Color fundus photograph.
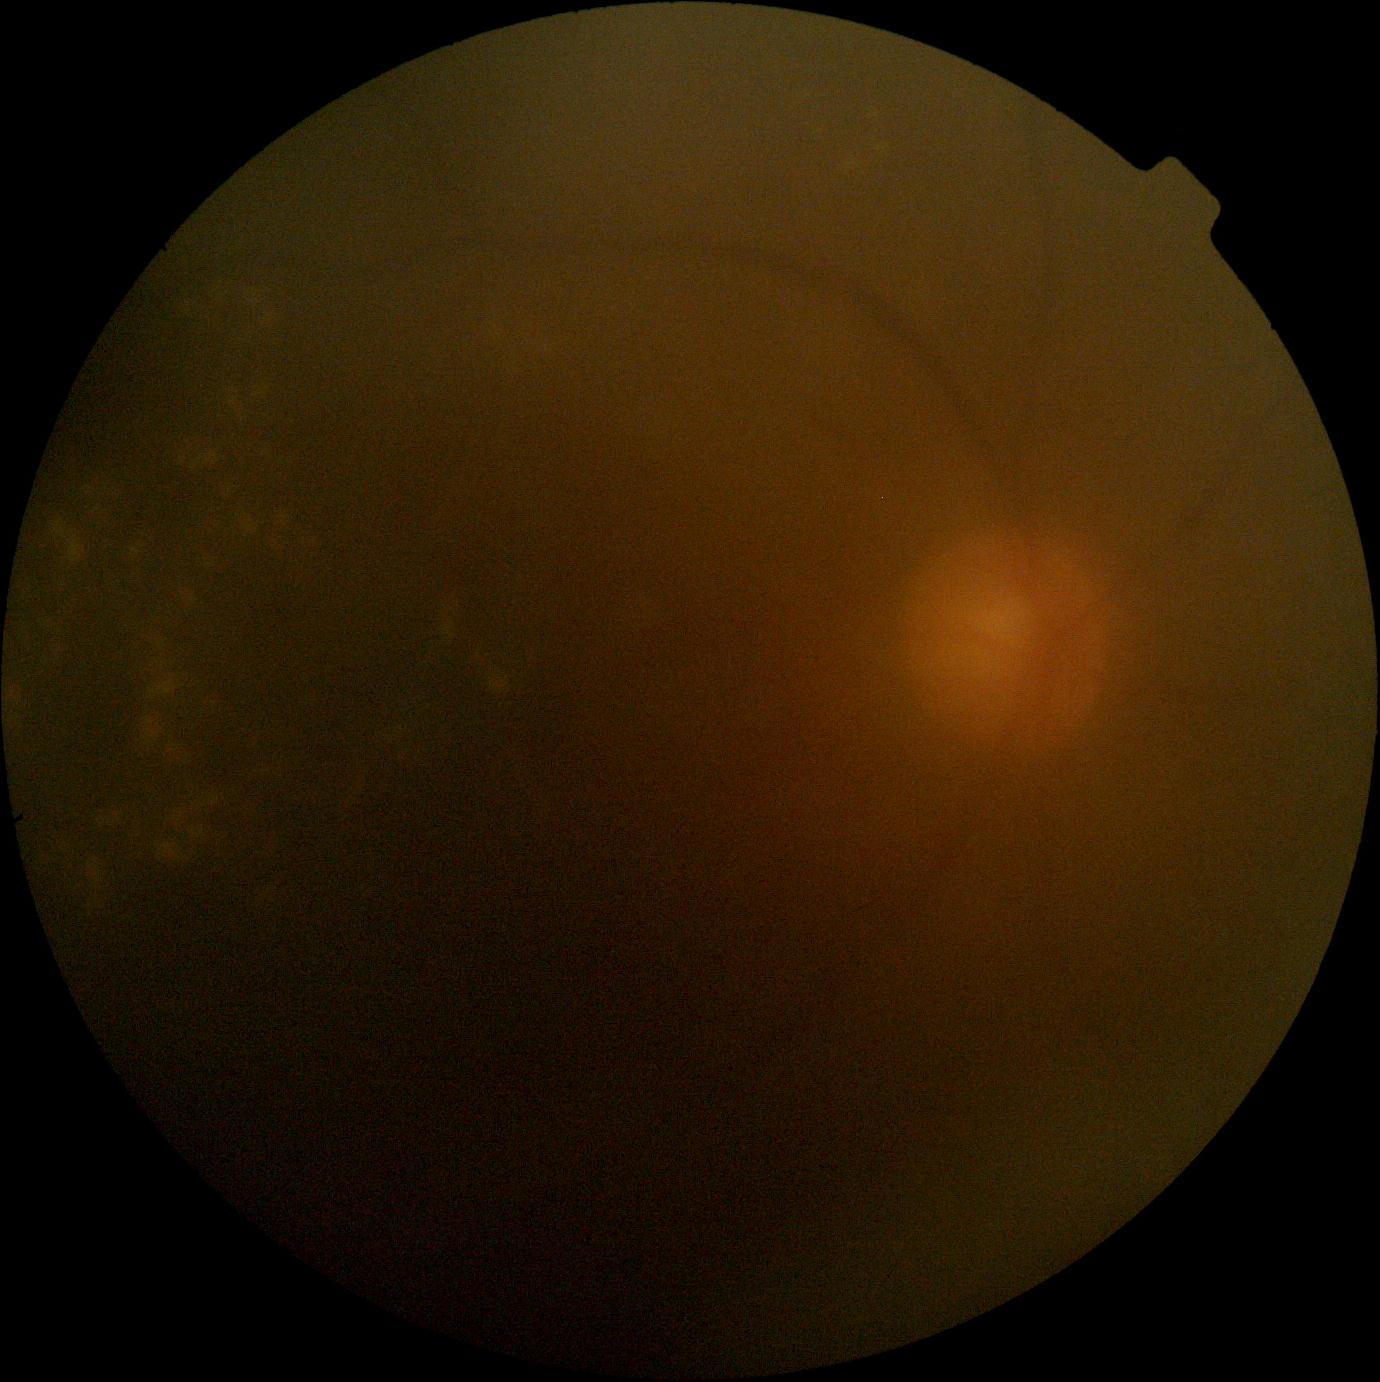 DR severity is grade 2 (moderate NPDR).